CFP; FOV: 45 degrees: 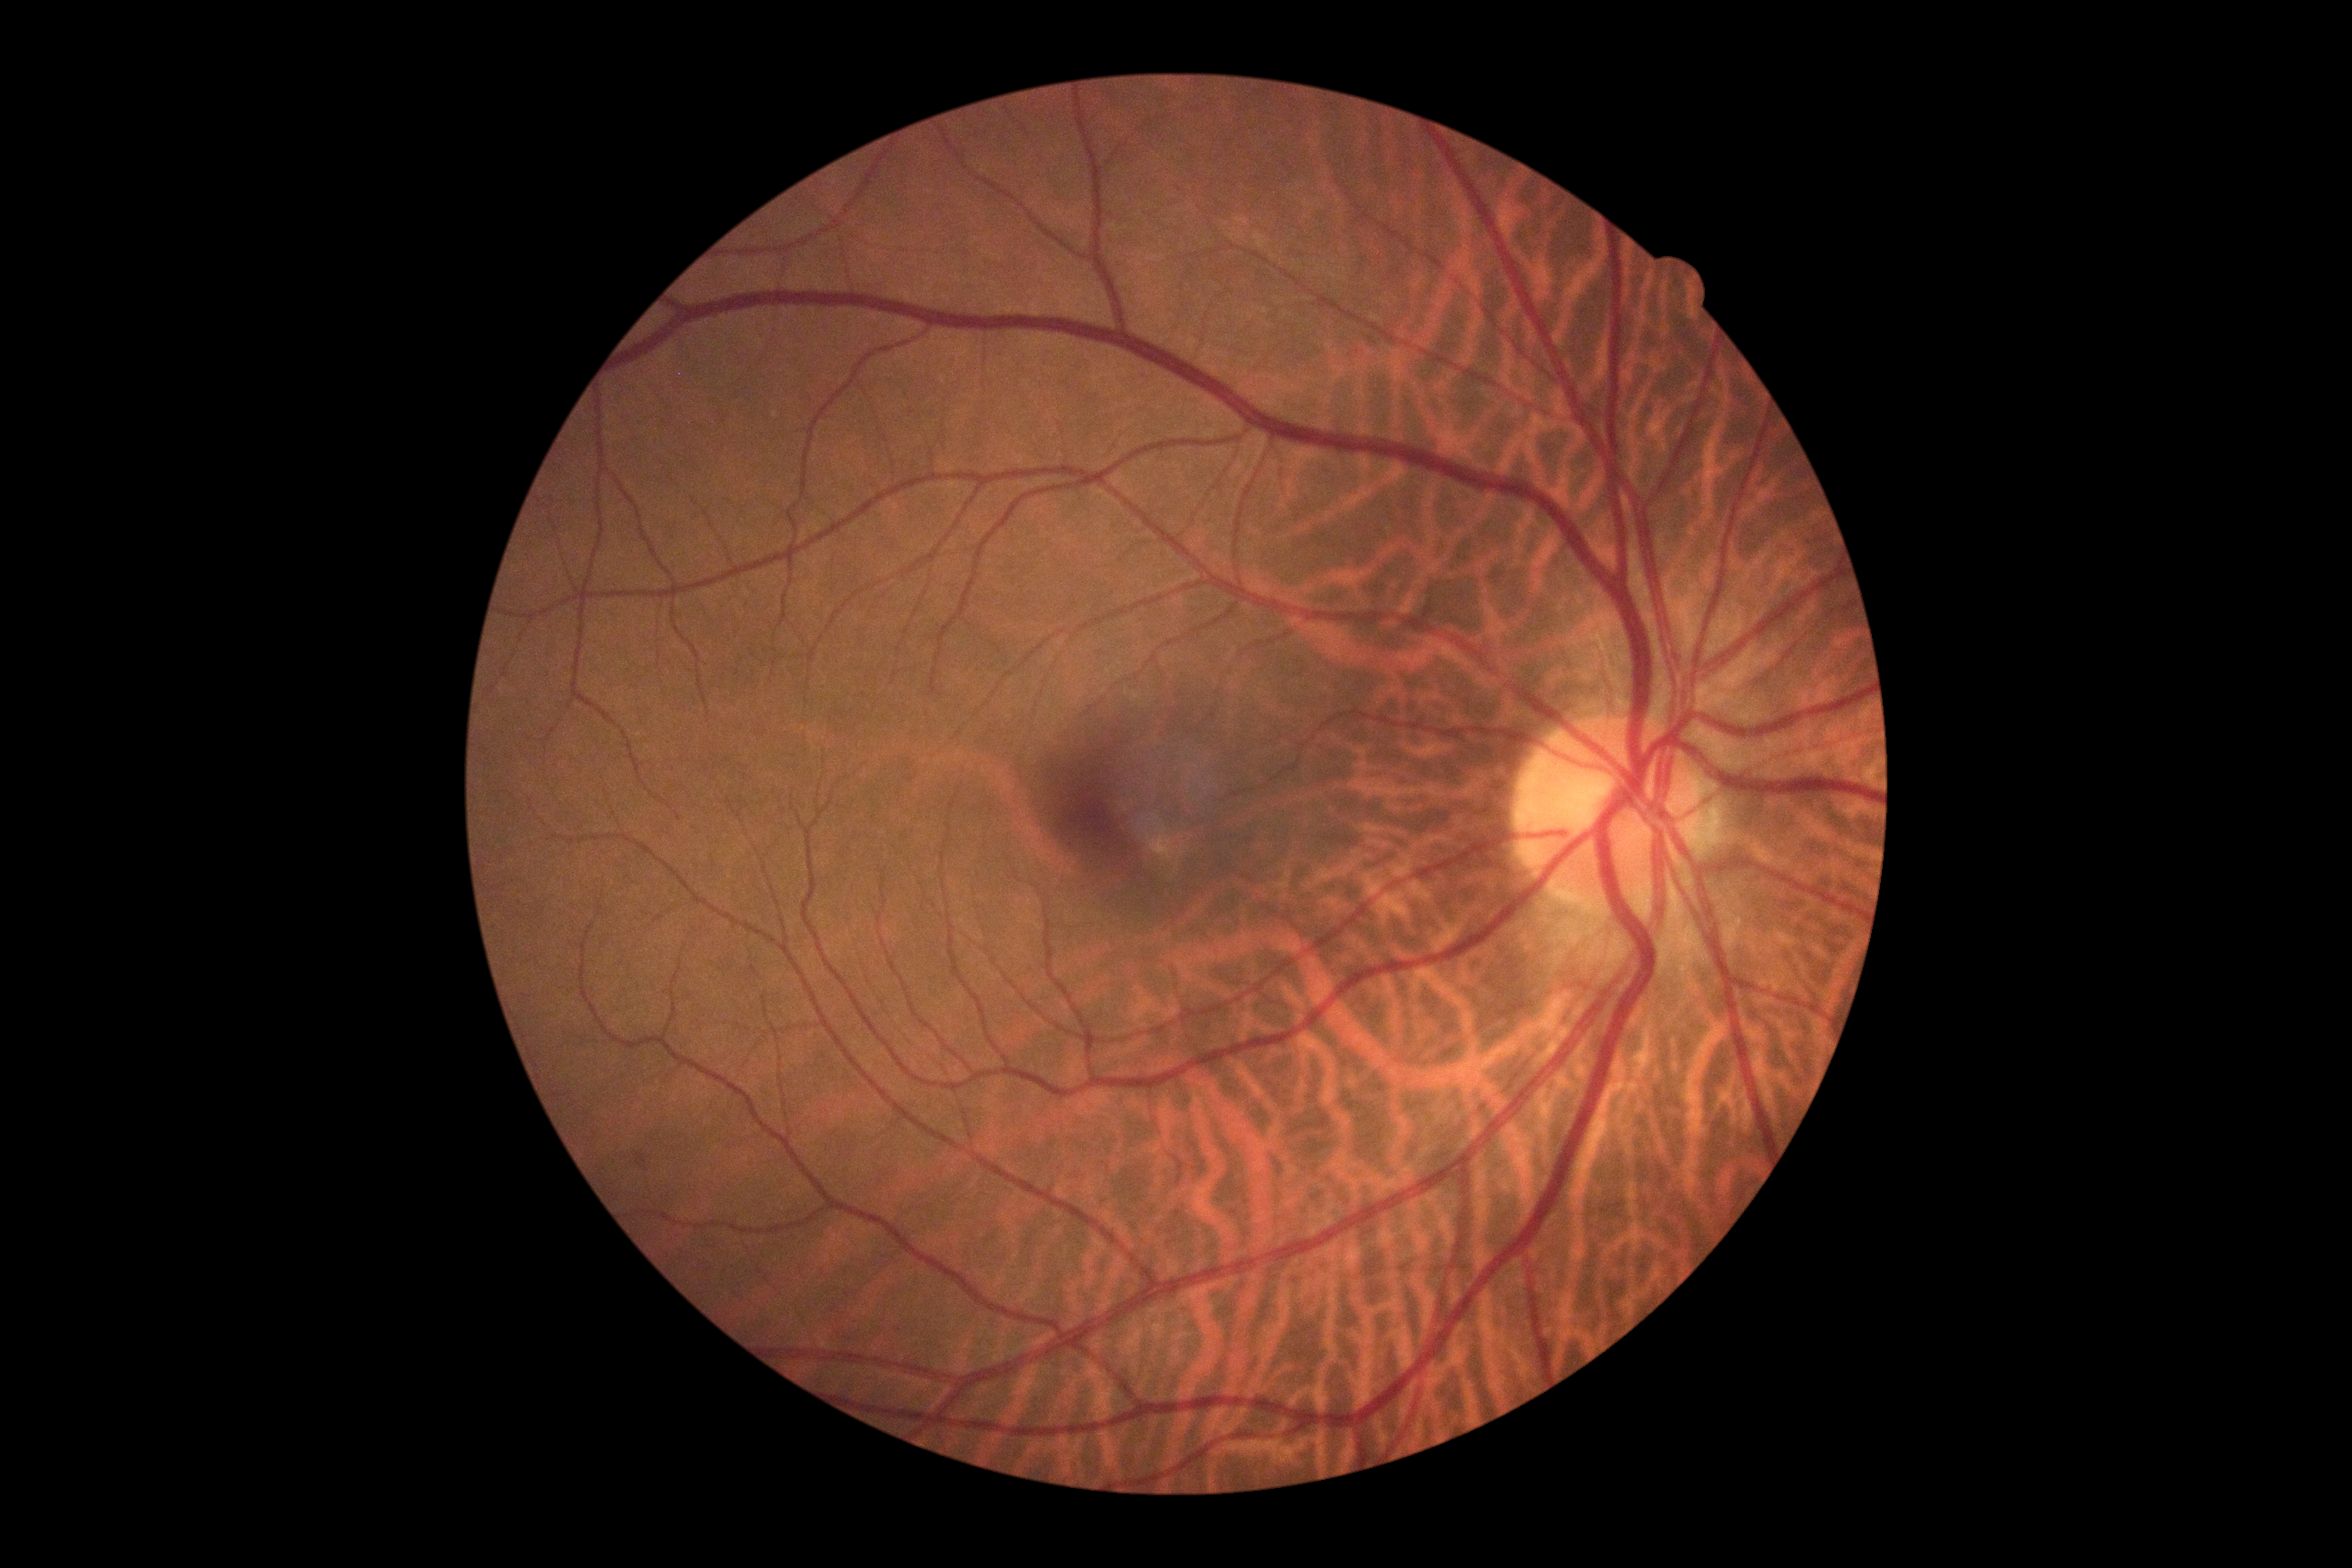 Retinopathy grade: 0 (no apparent retinopathy) — no visible signs of diabetic retinopathy.